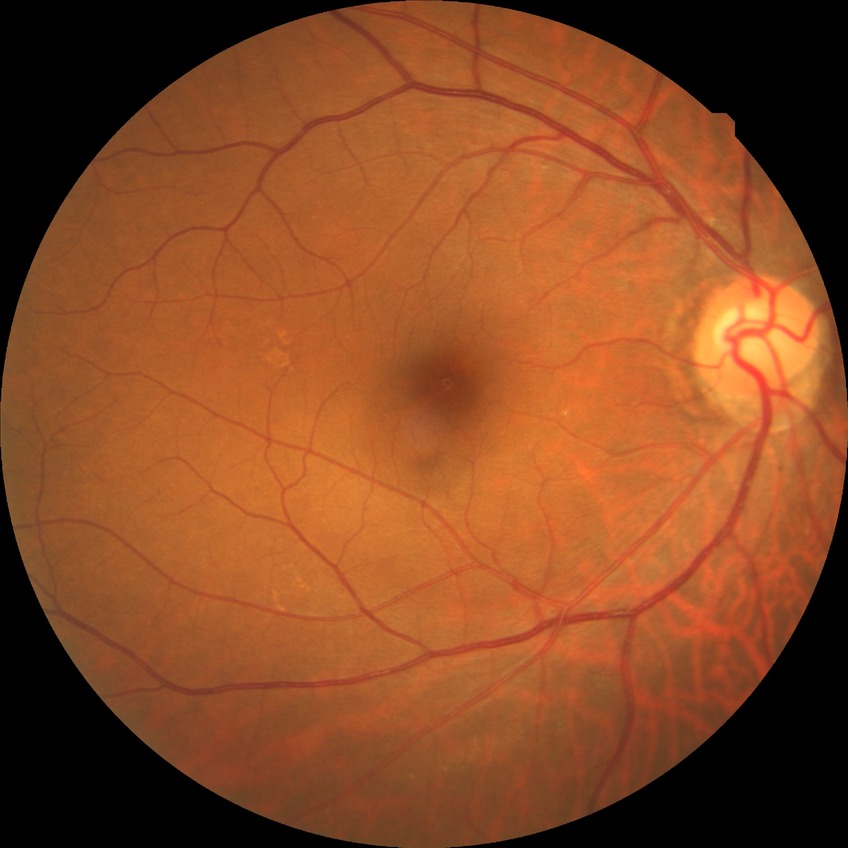

Diabetic retinopathy stage: no diabetic retinopathy.